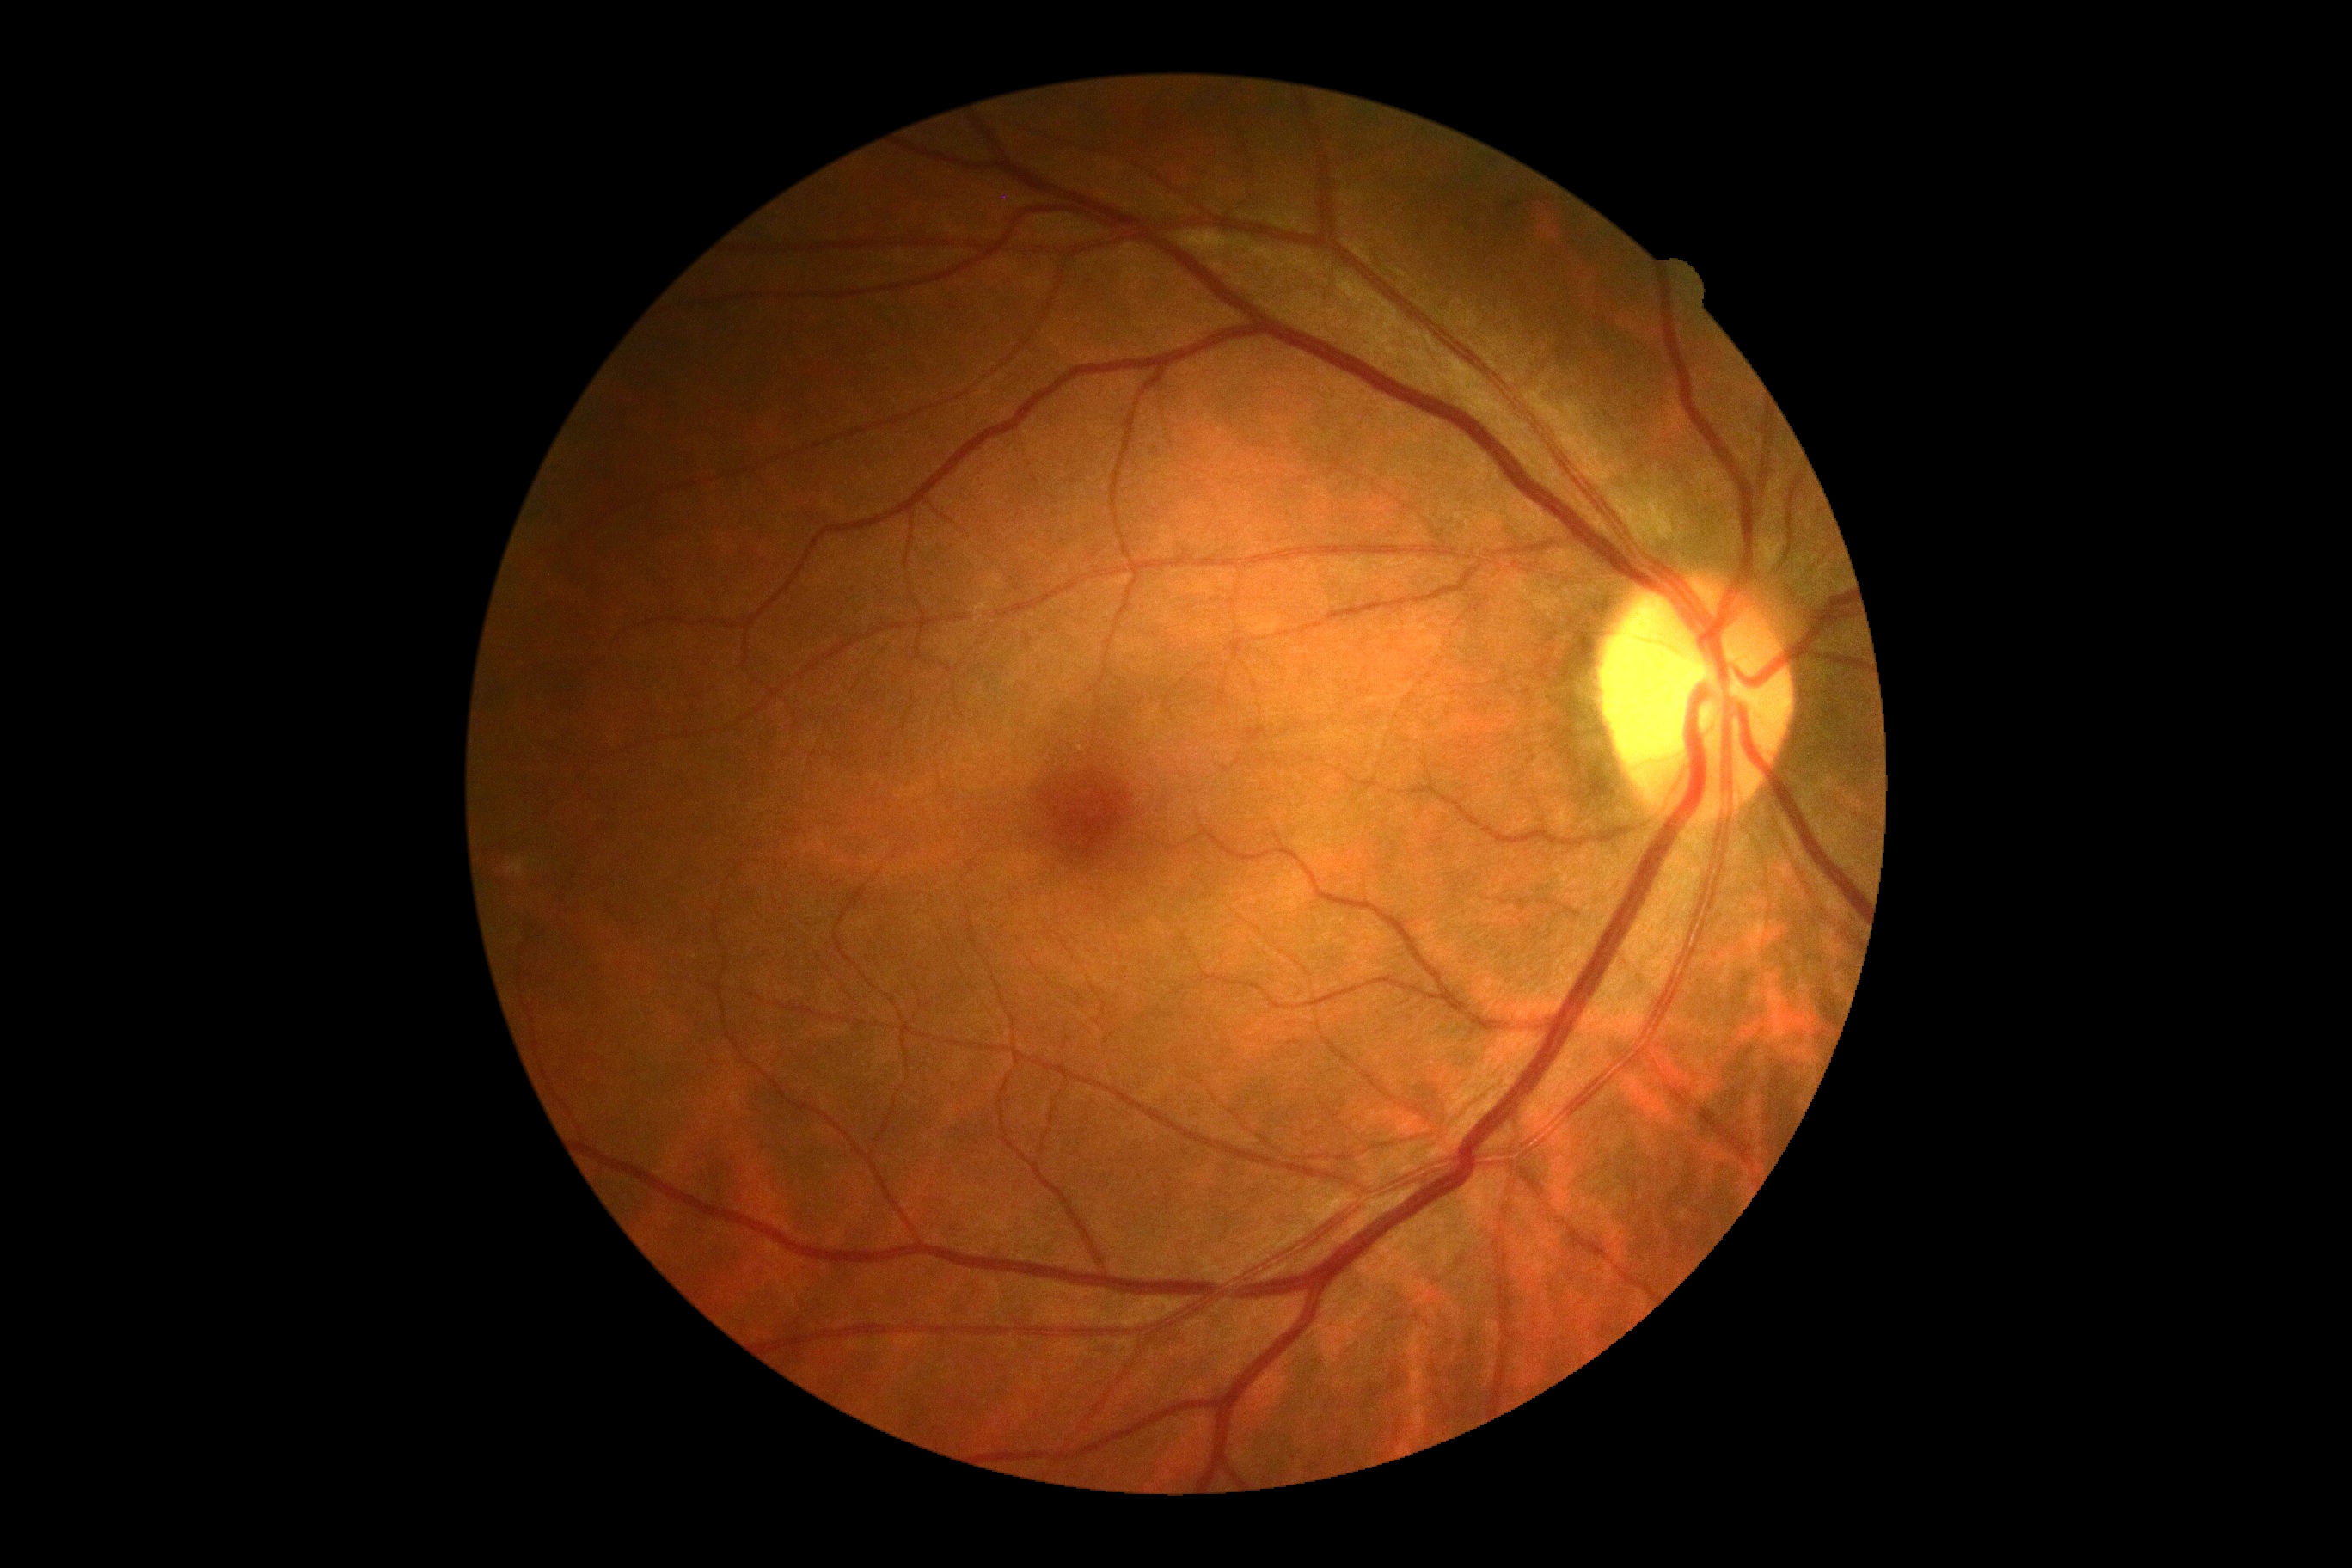
DR = 0/4